45° field of view; 2352x1568px; retinal fundus photograph.
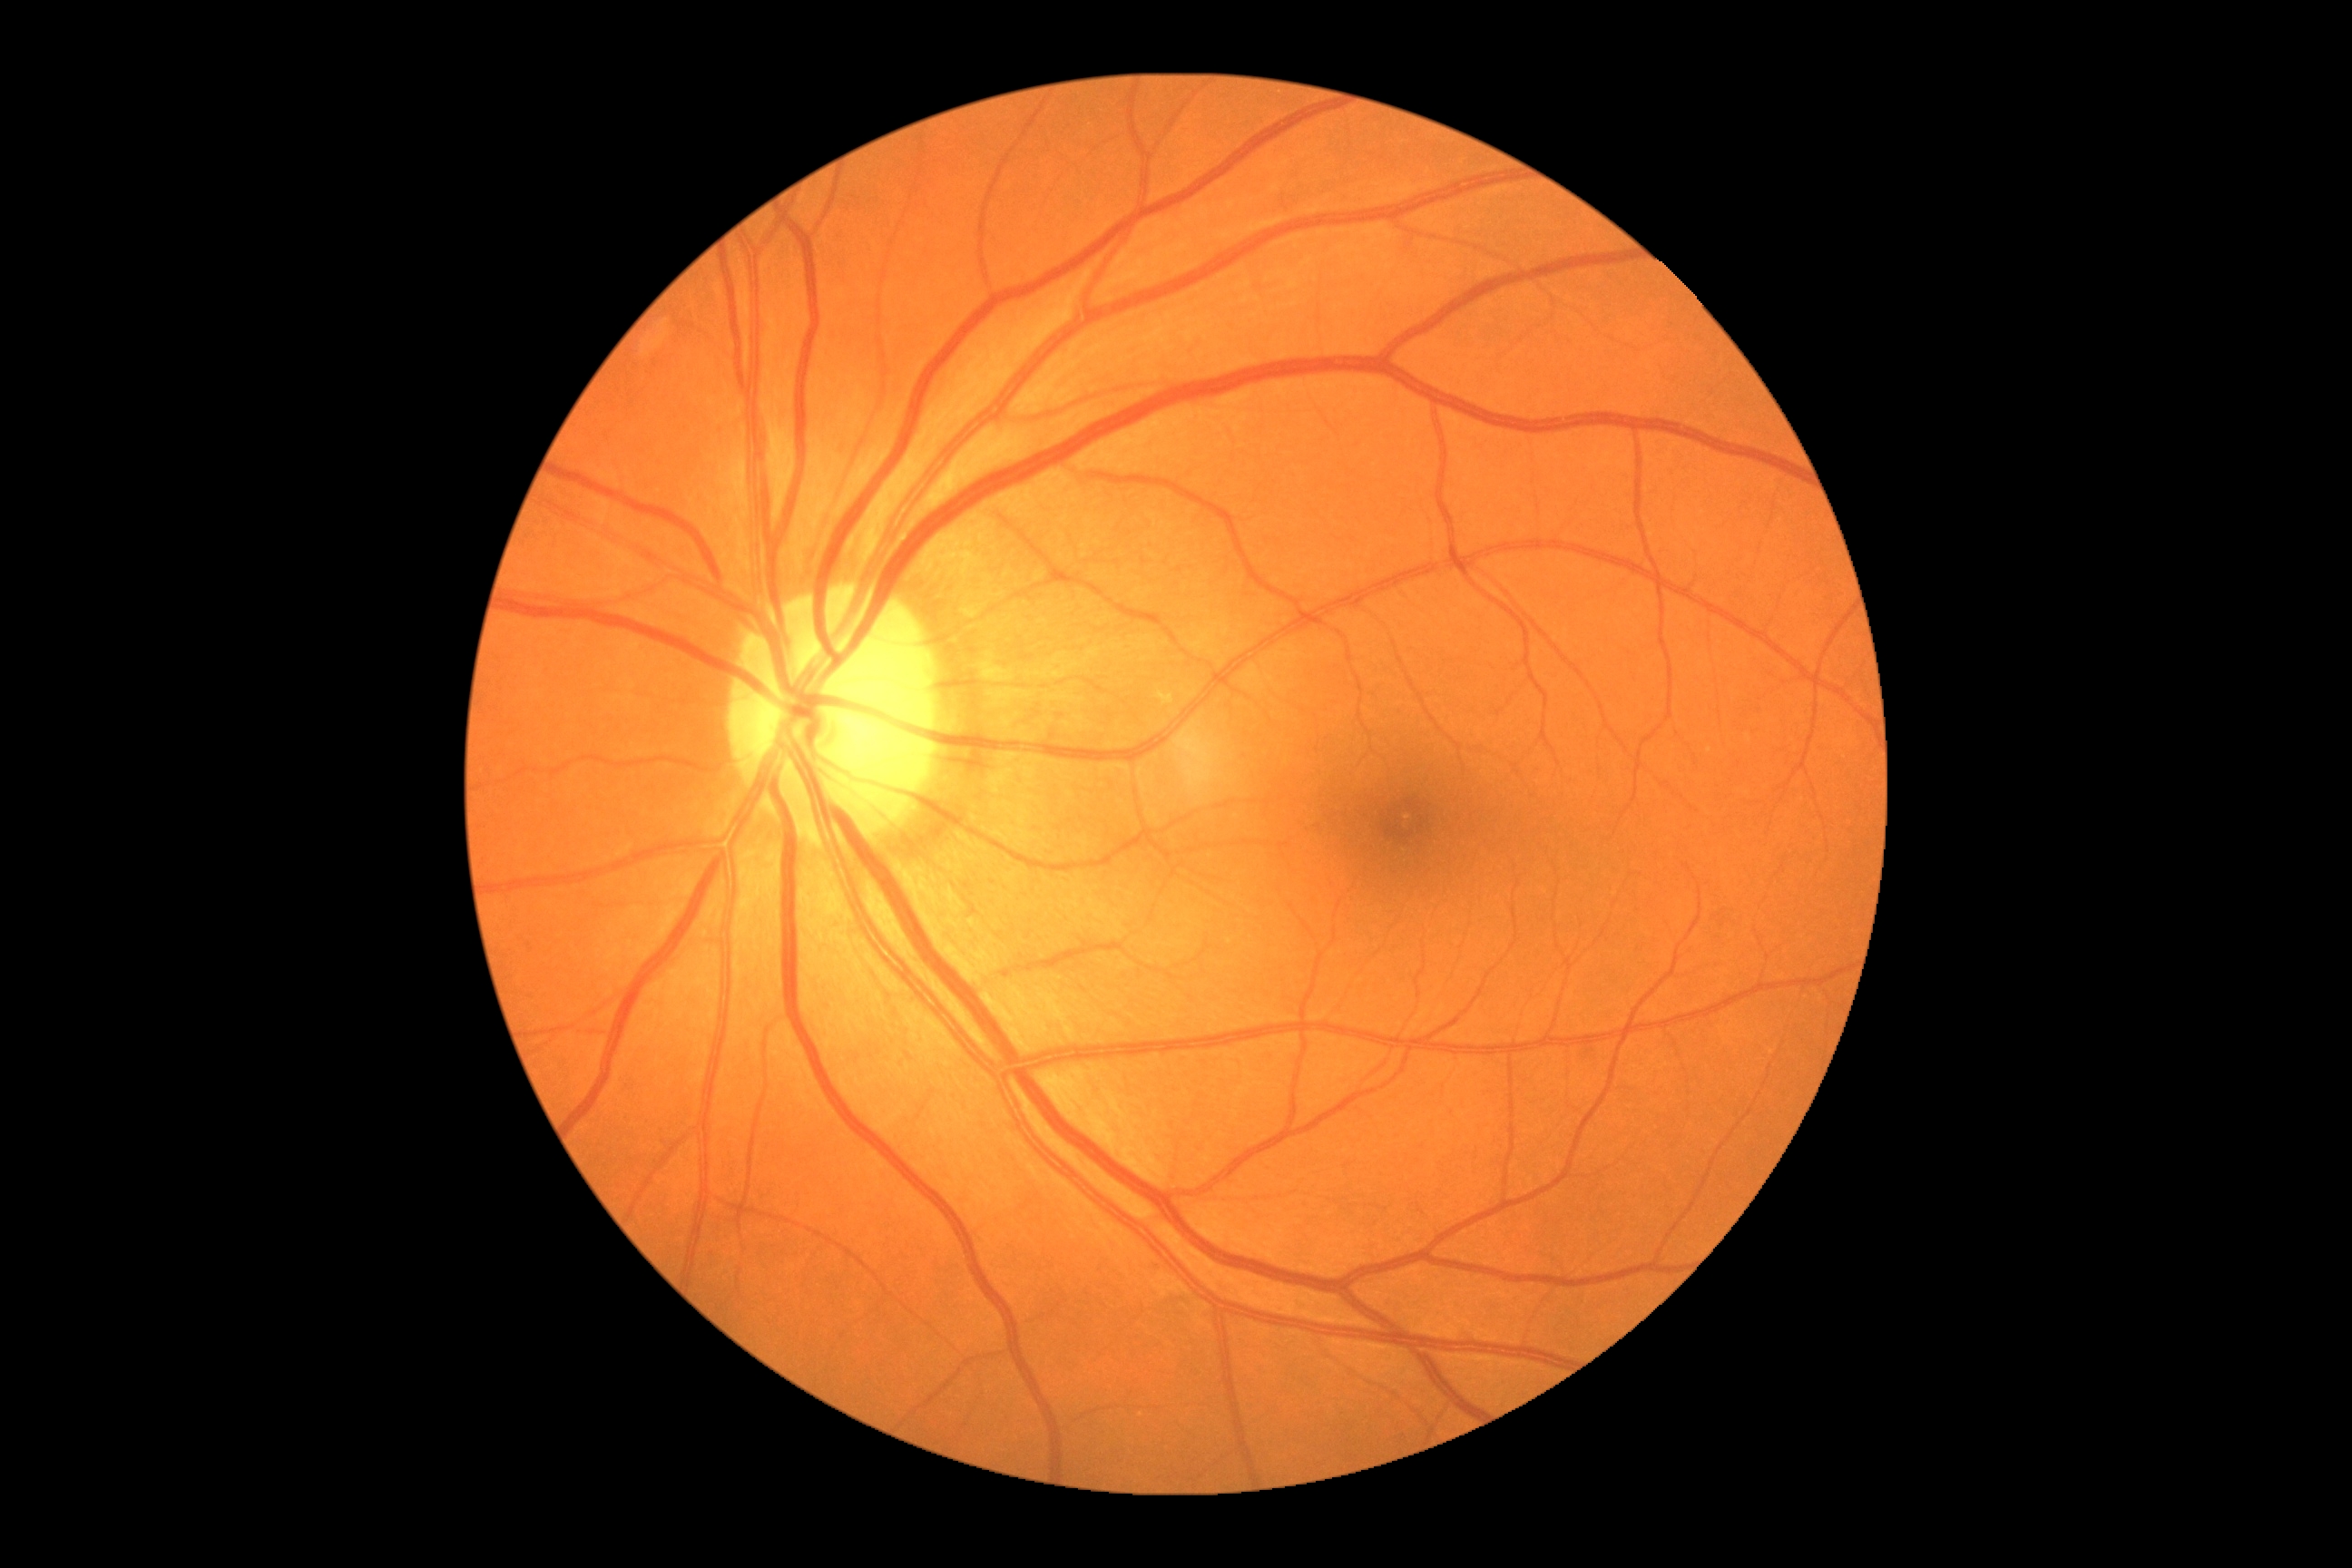

Findings:
– DR severity — 0